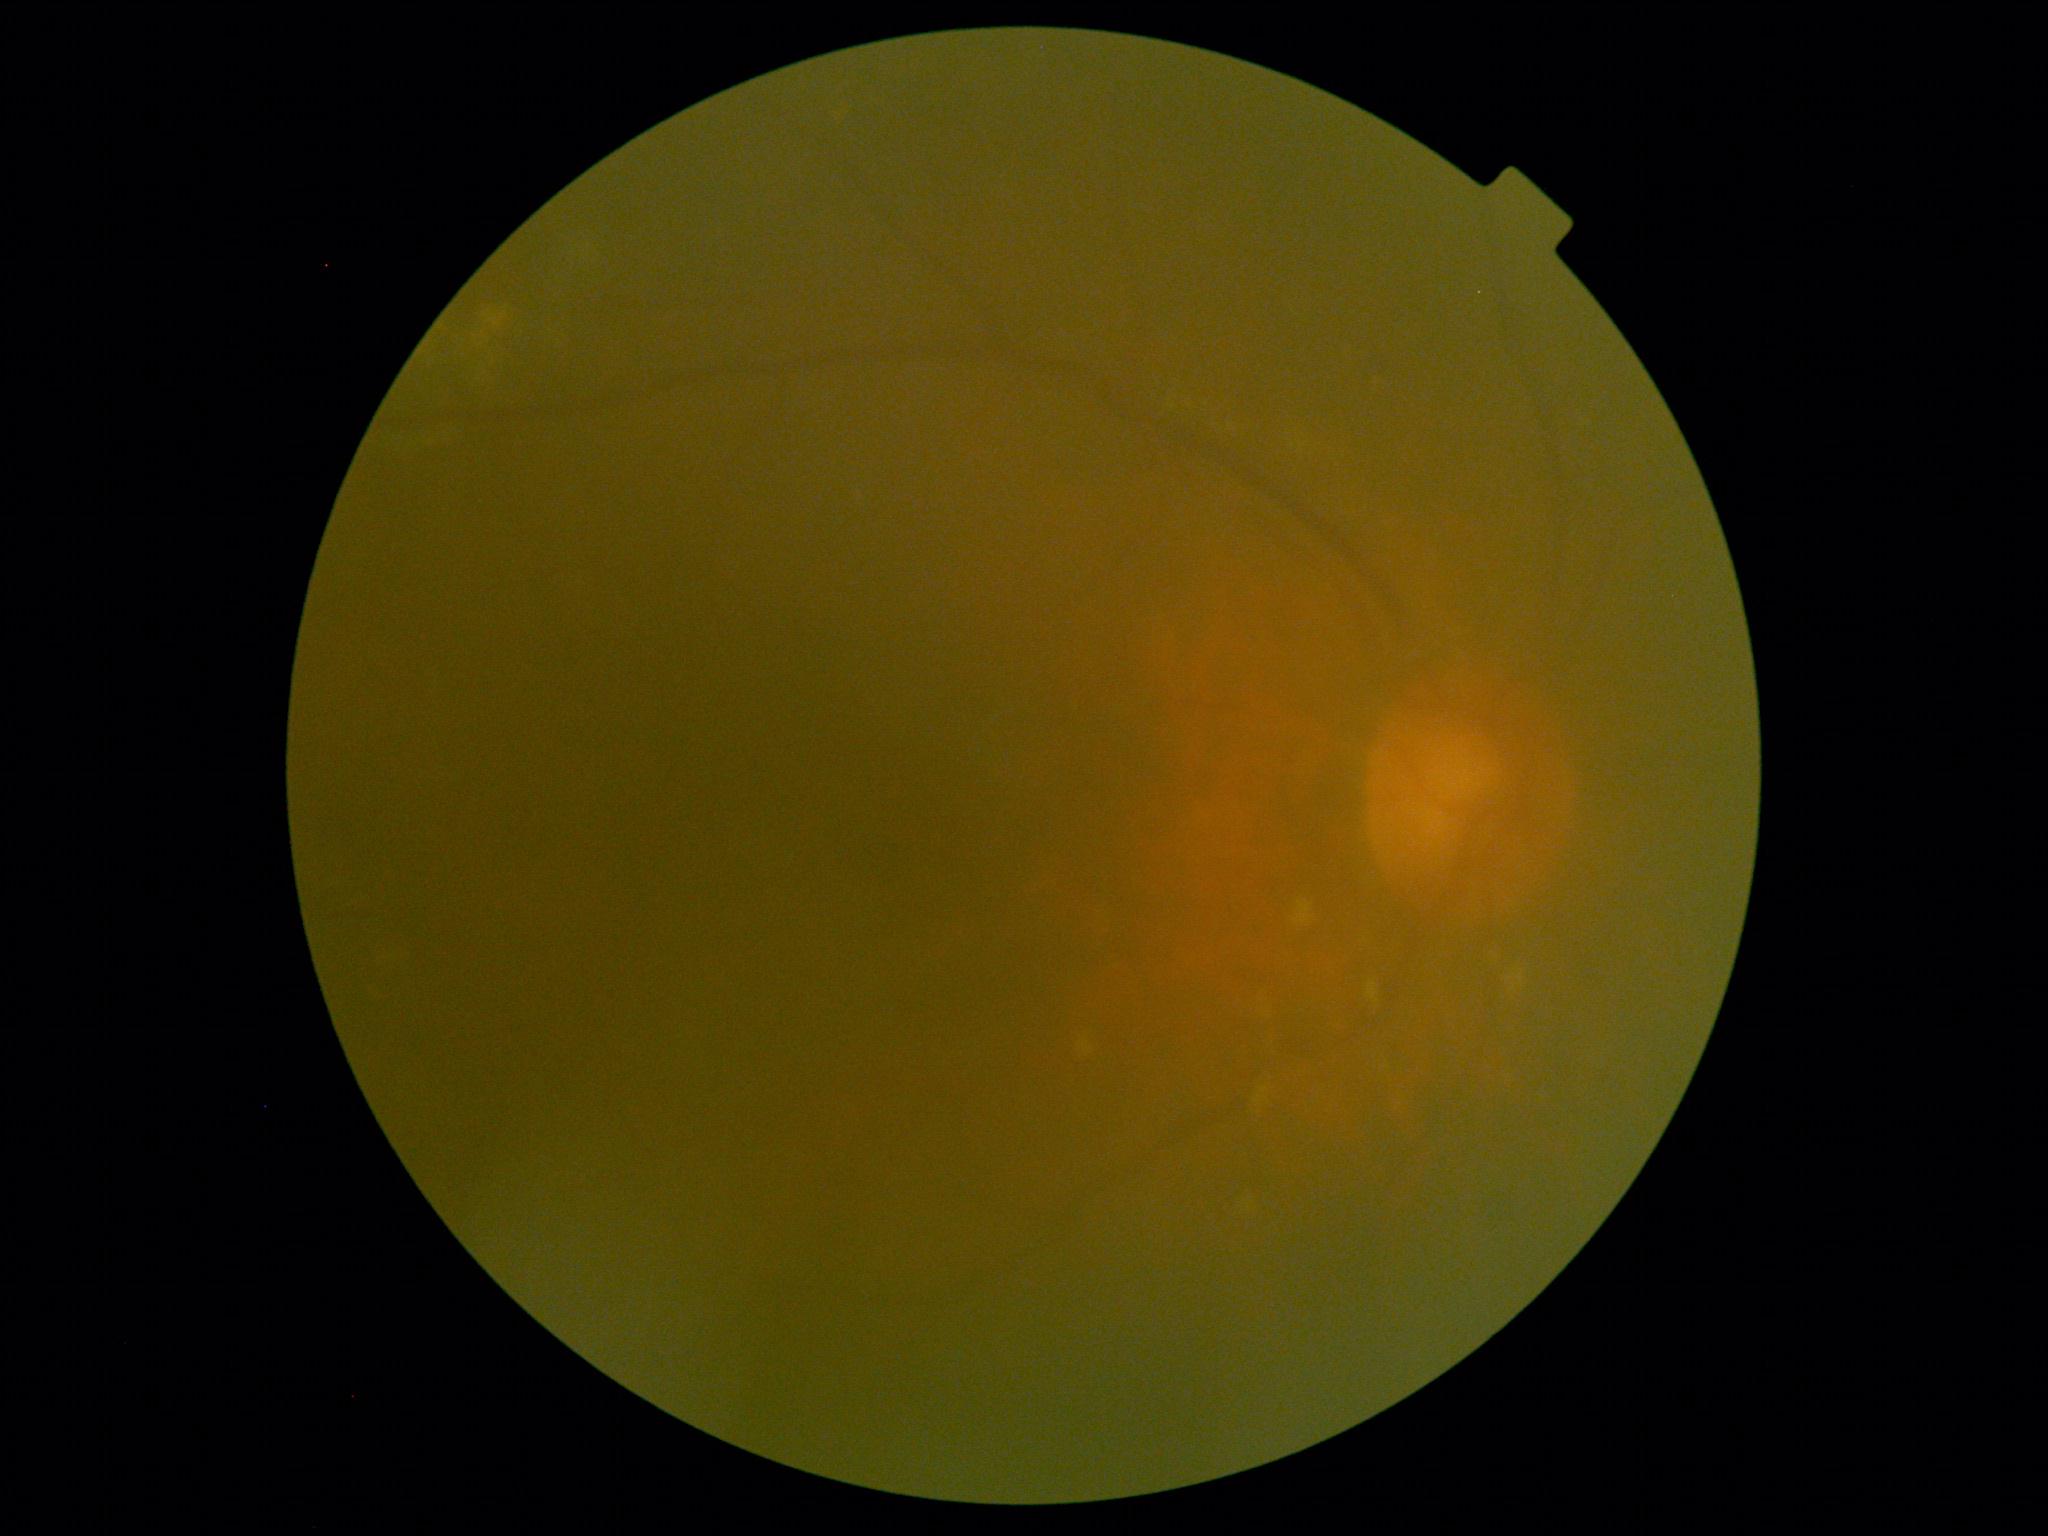

Annotations:
* DR: ungradable due to poor image quality
* image quality: insufficient